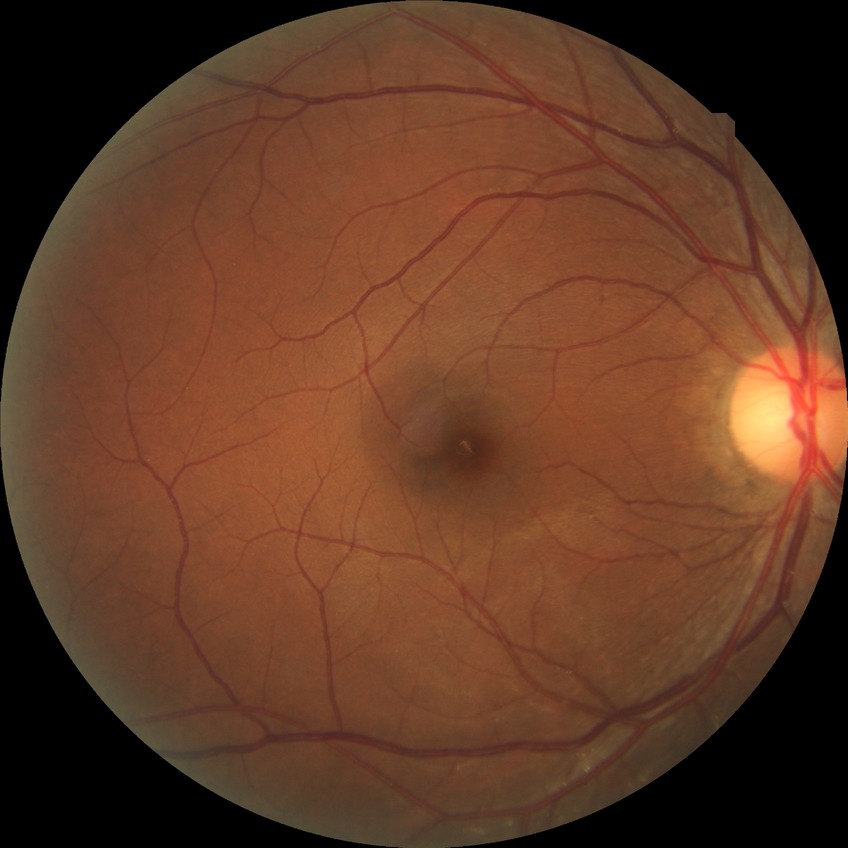 {"davis_grade": "NDR"}